45-degree field of view · color fundus image.
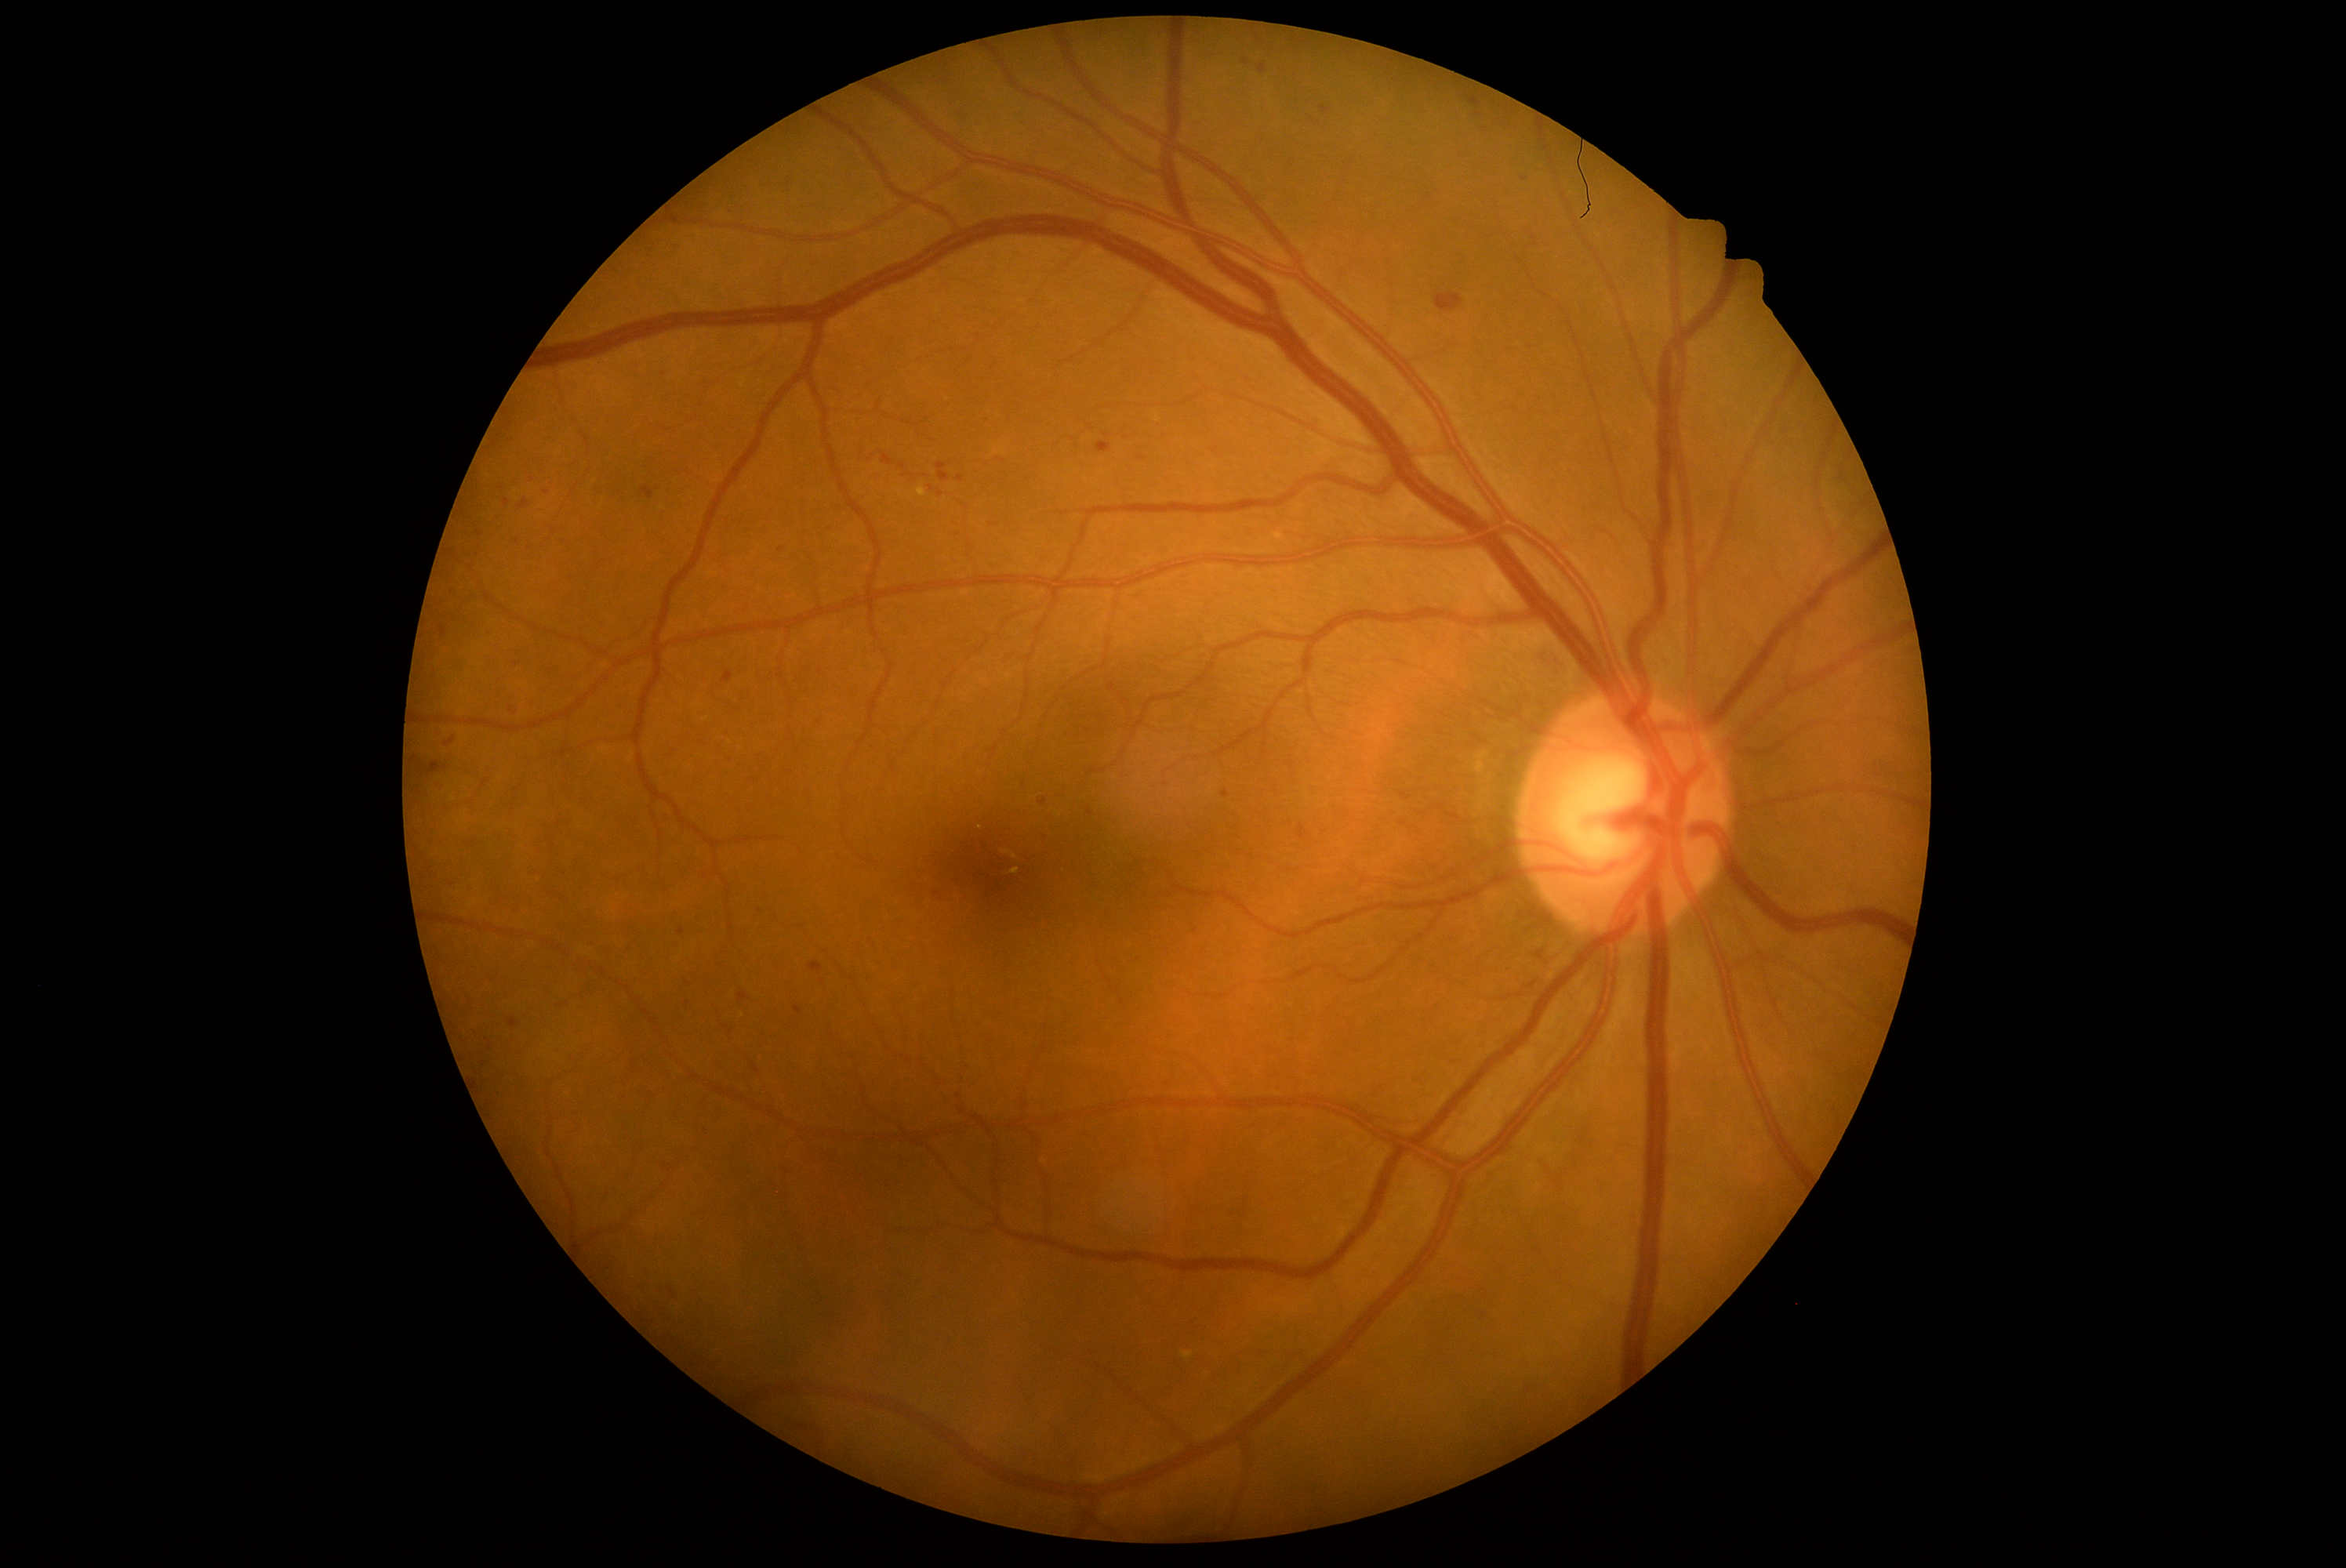 <lesions partial="true">
  <dr_grade>2</dr_grade>
  <he partial="true">[451,551,457,559] | [937,463,950,482] | [1037,832,1050,846] | [892,1269,907,1283] | [510,1018,518,1028] | [482,1034,490,1042] | [1299,824,1309,840] | [738,993,750,1001] | [485,626,496,637] | [518,499,529,509] | [1306,115,1327,131]</he>
  <he_small_centers>point(681, 932) | point(1535, 245) | point(1533, 237) | point(688, 1004) | point(532, 481) | point(820, 672)</he_small_centers>
</lesions>